Color fundus photograph:
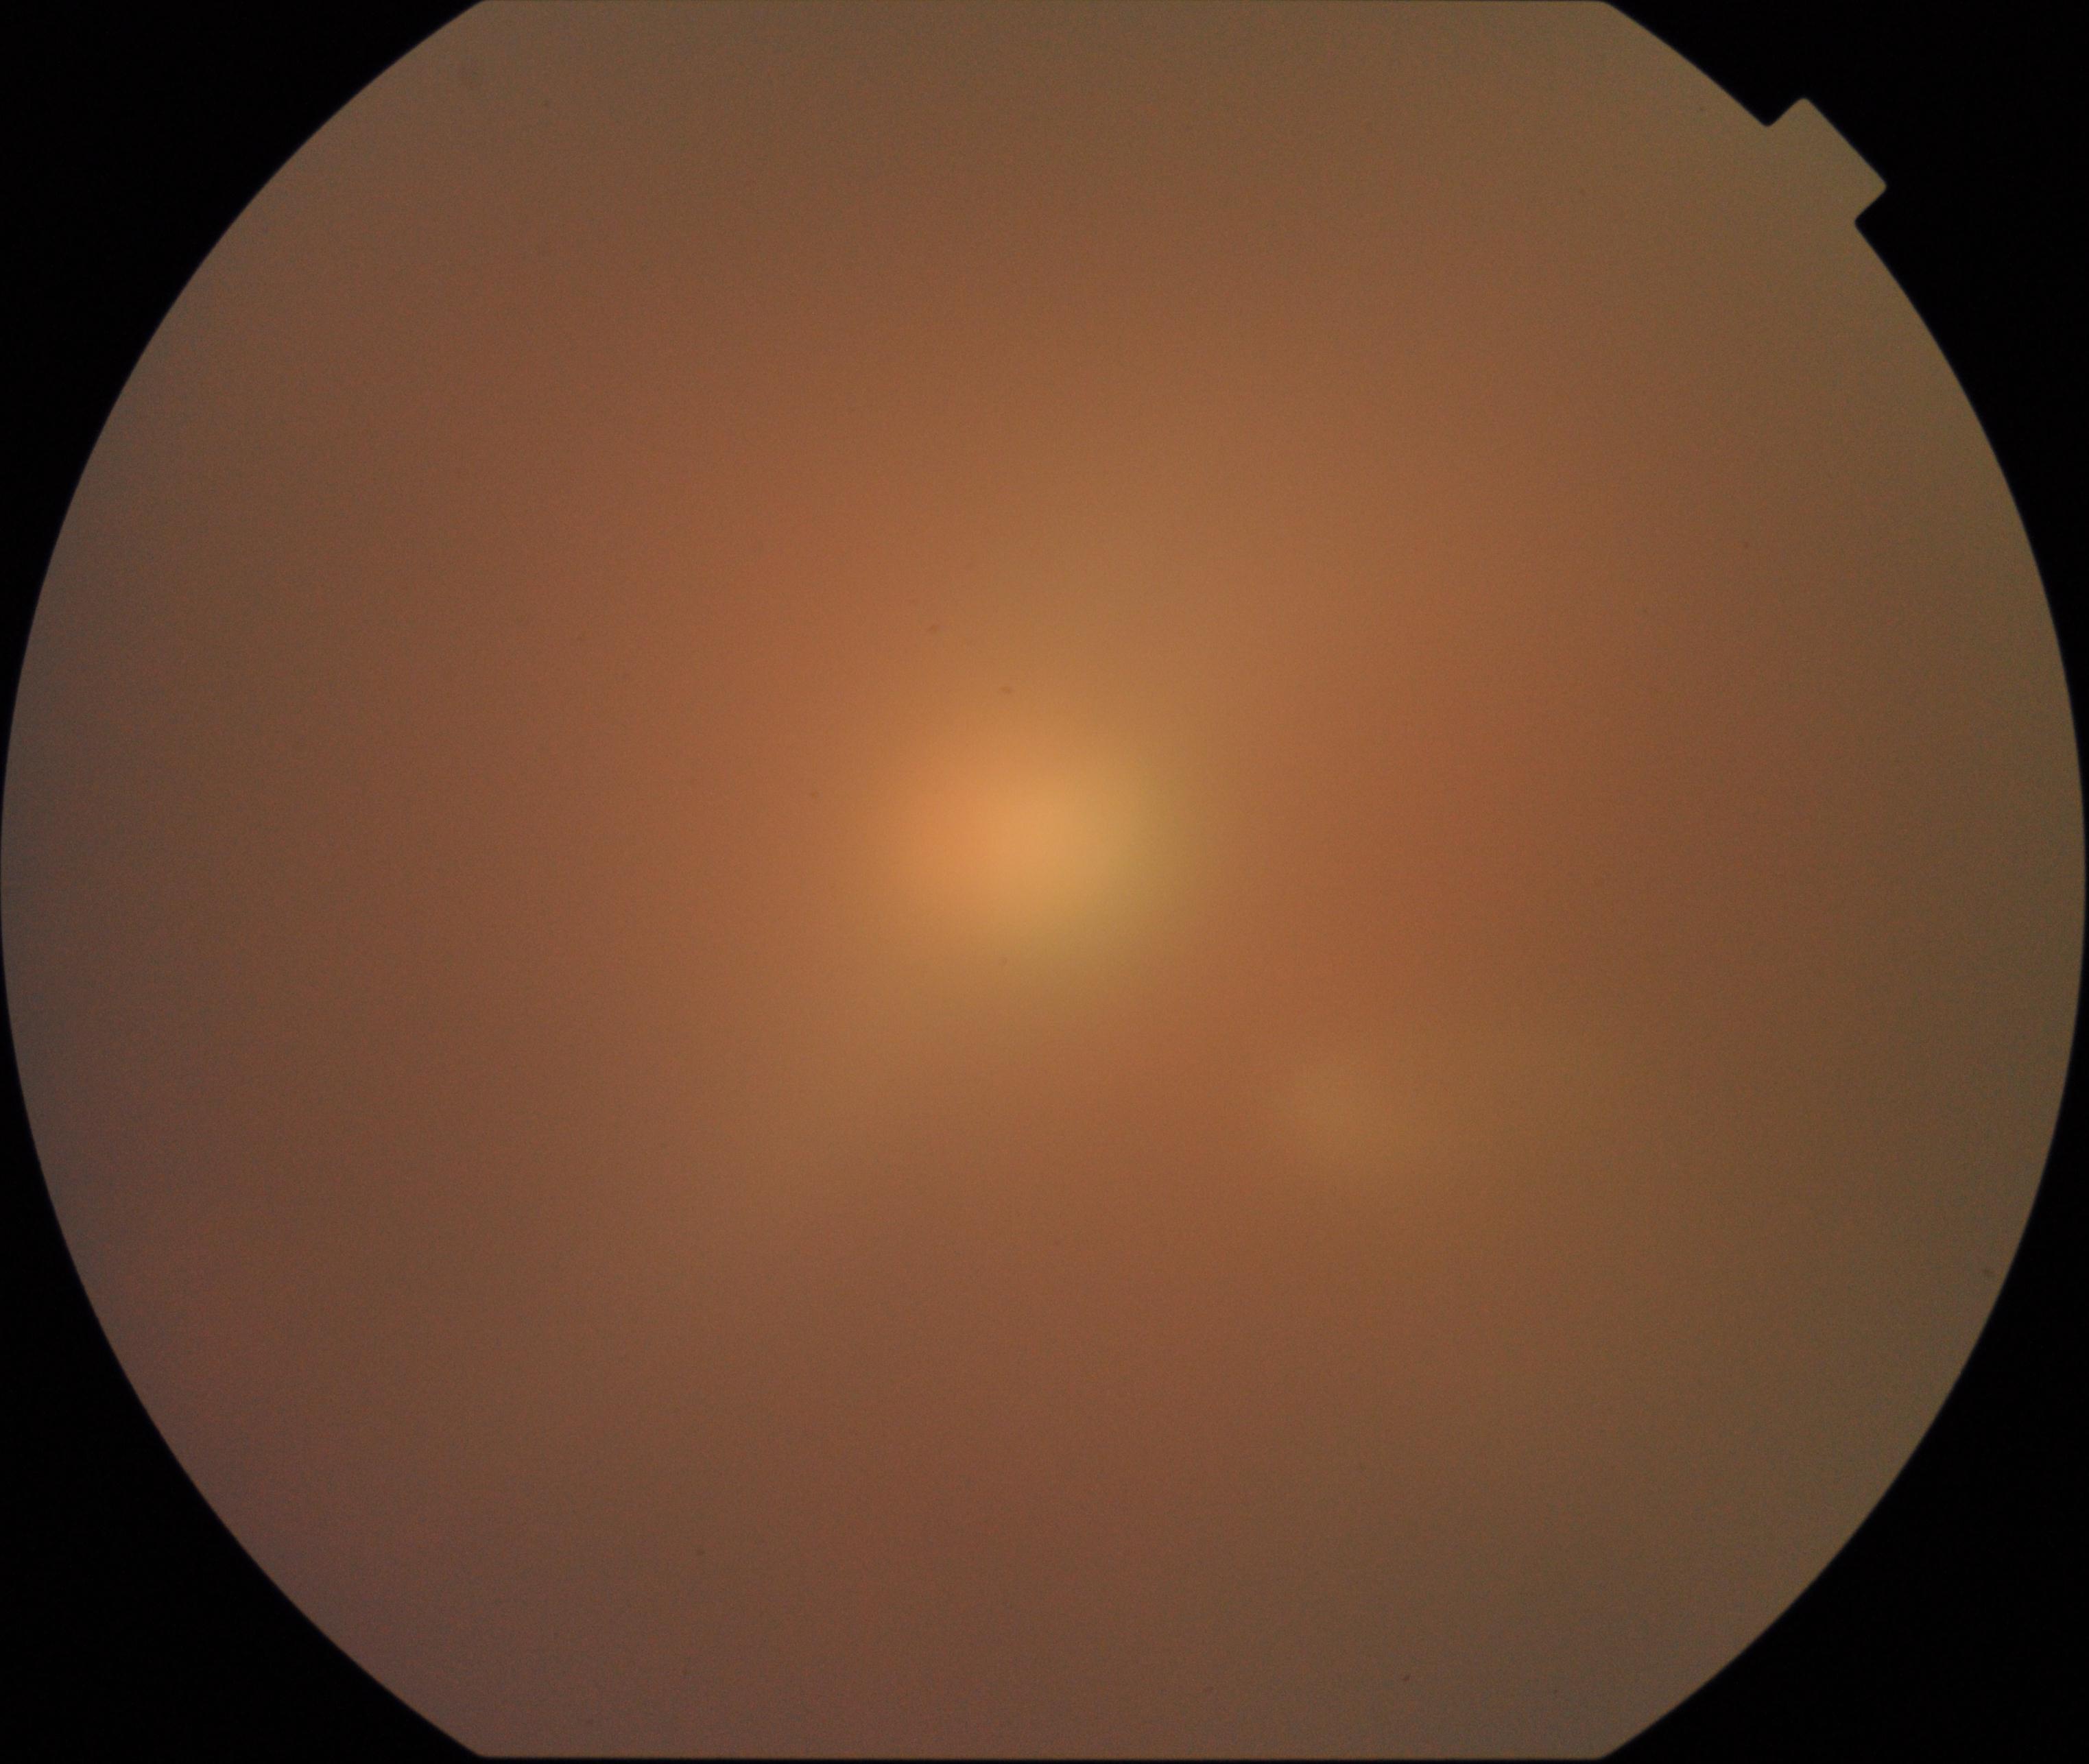 Image quality: significantly degraded.
Proliferative retinopathy: not identified.